CFP; axial length 23.62 mm; sex: F
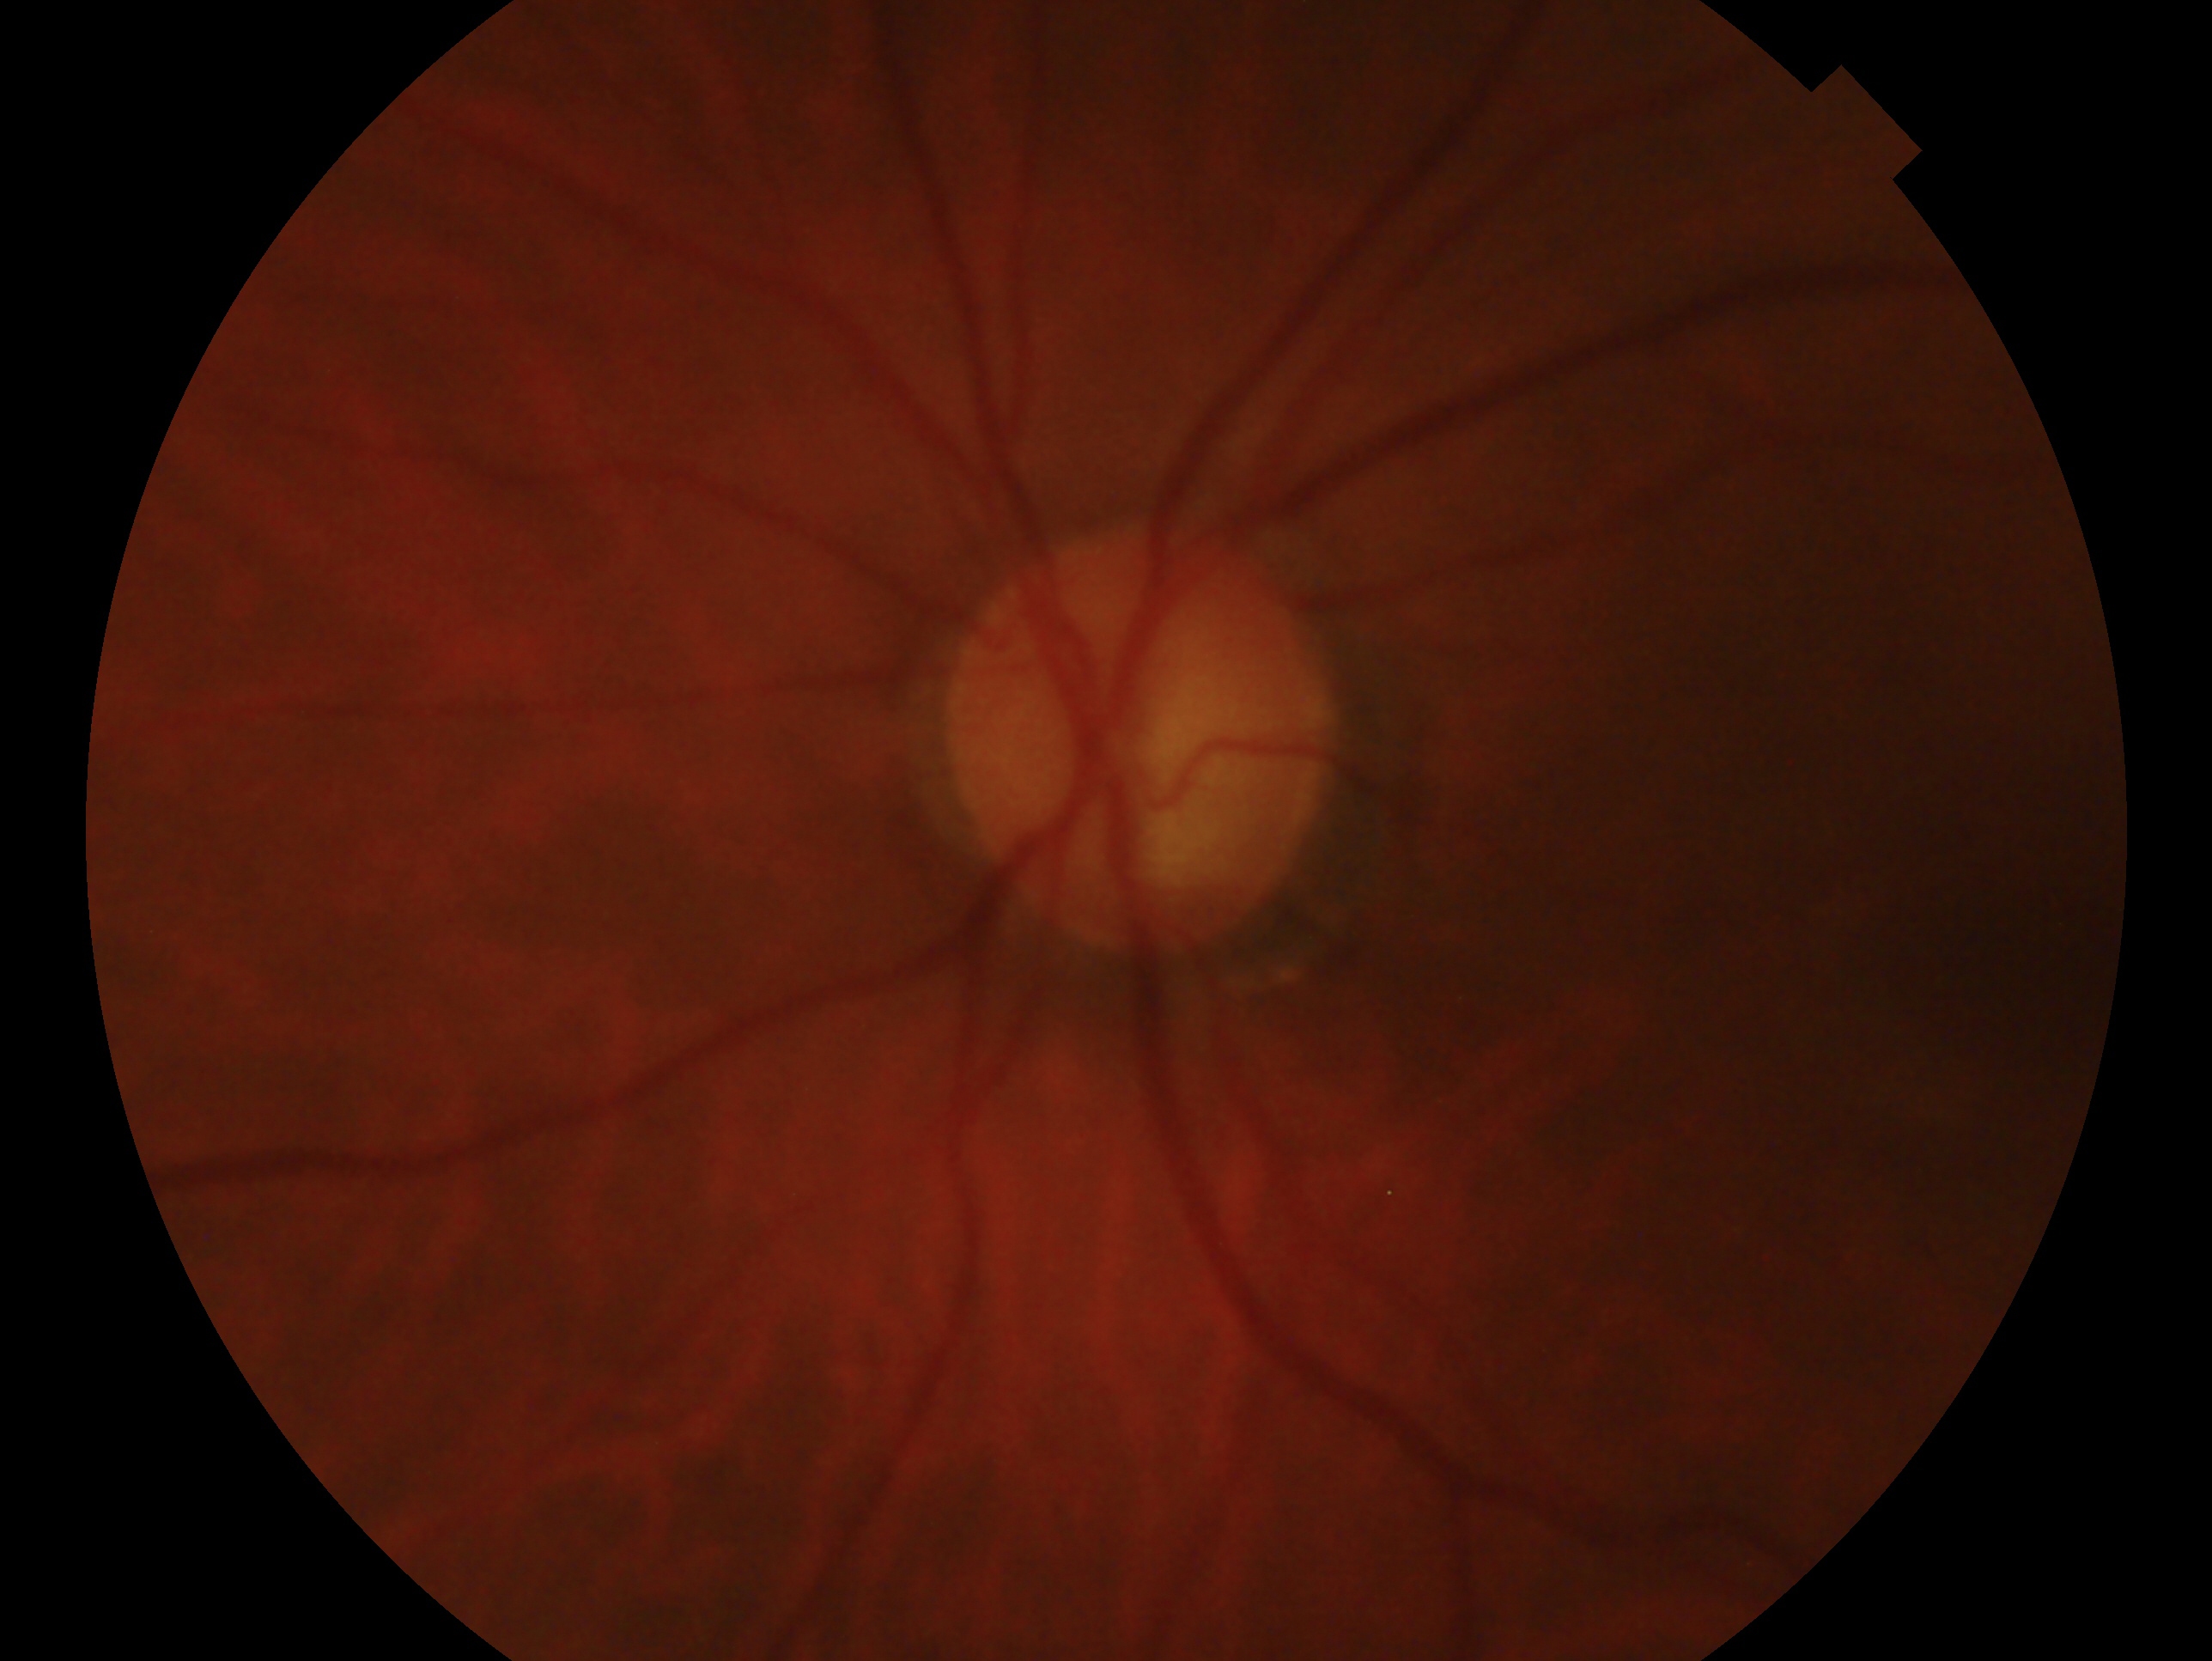
glaucoma_dx: consistent with glaucoma
eye: OS